Macula at the center of the field, FOV: 50 degrees:
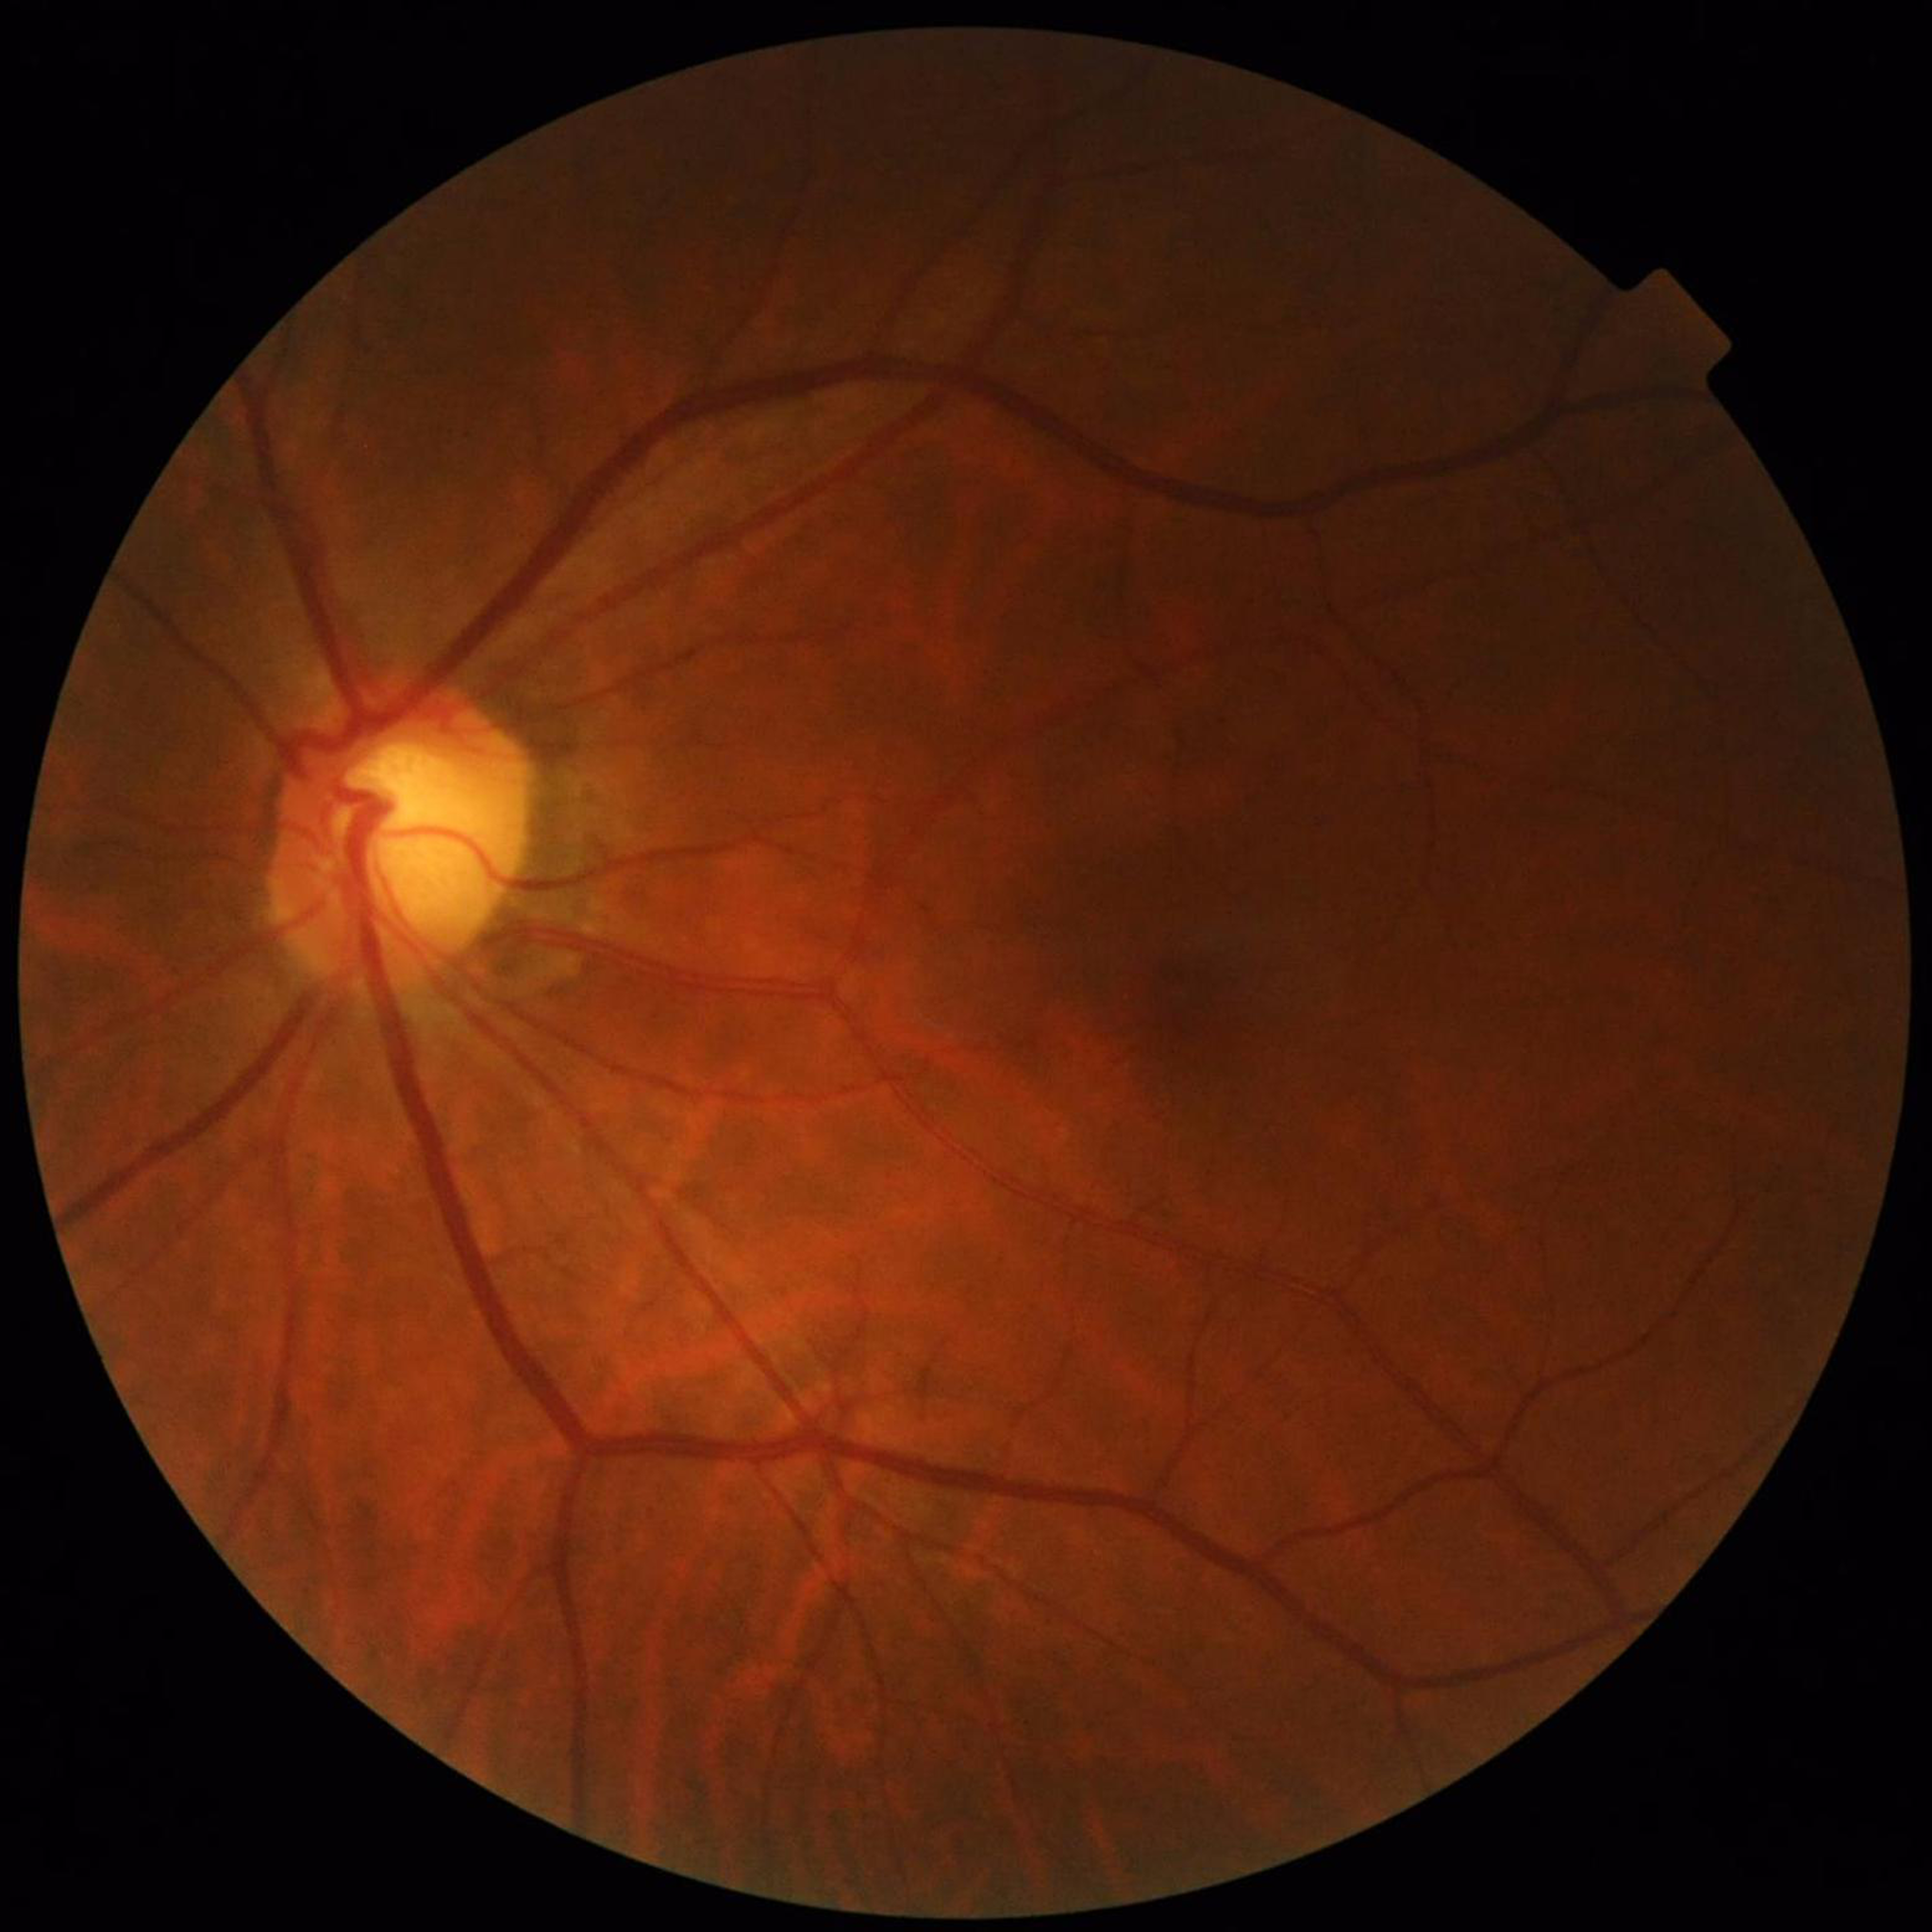
diagnosis: glaucoma